1924x1556, fundus photo: 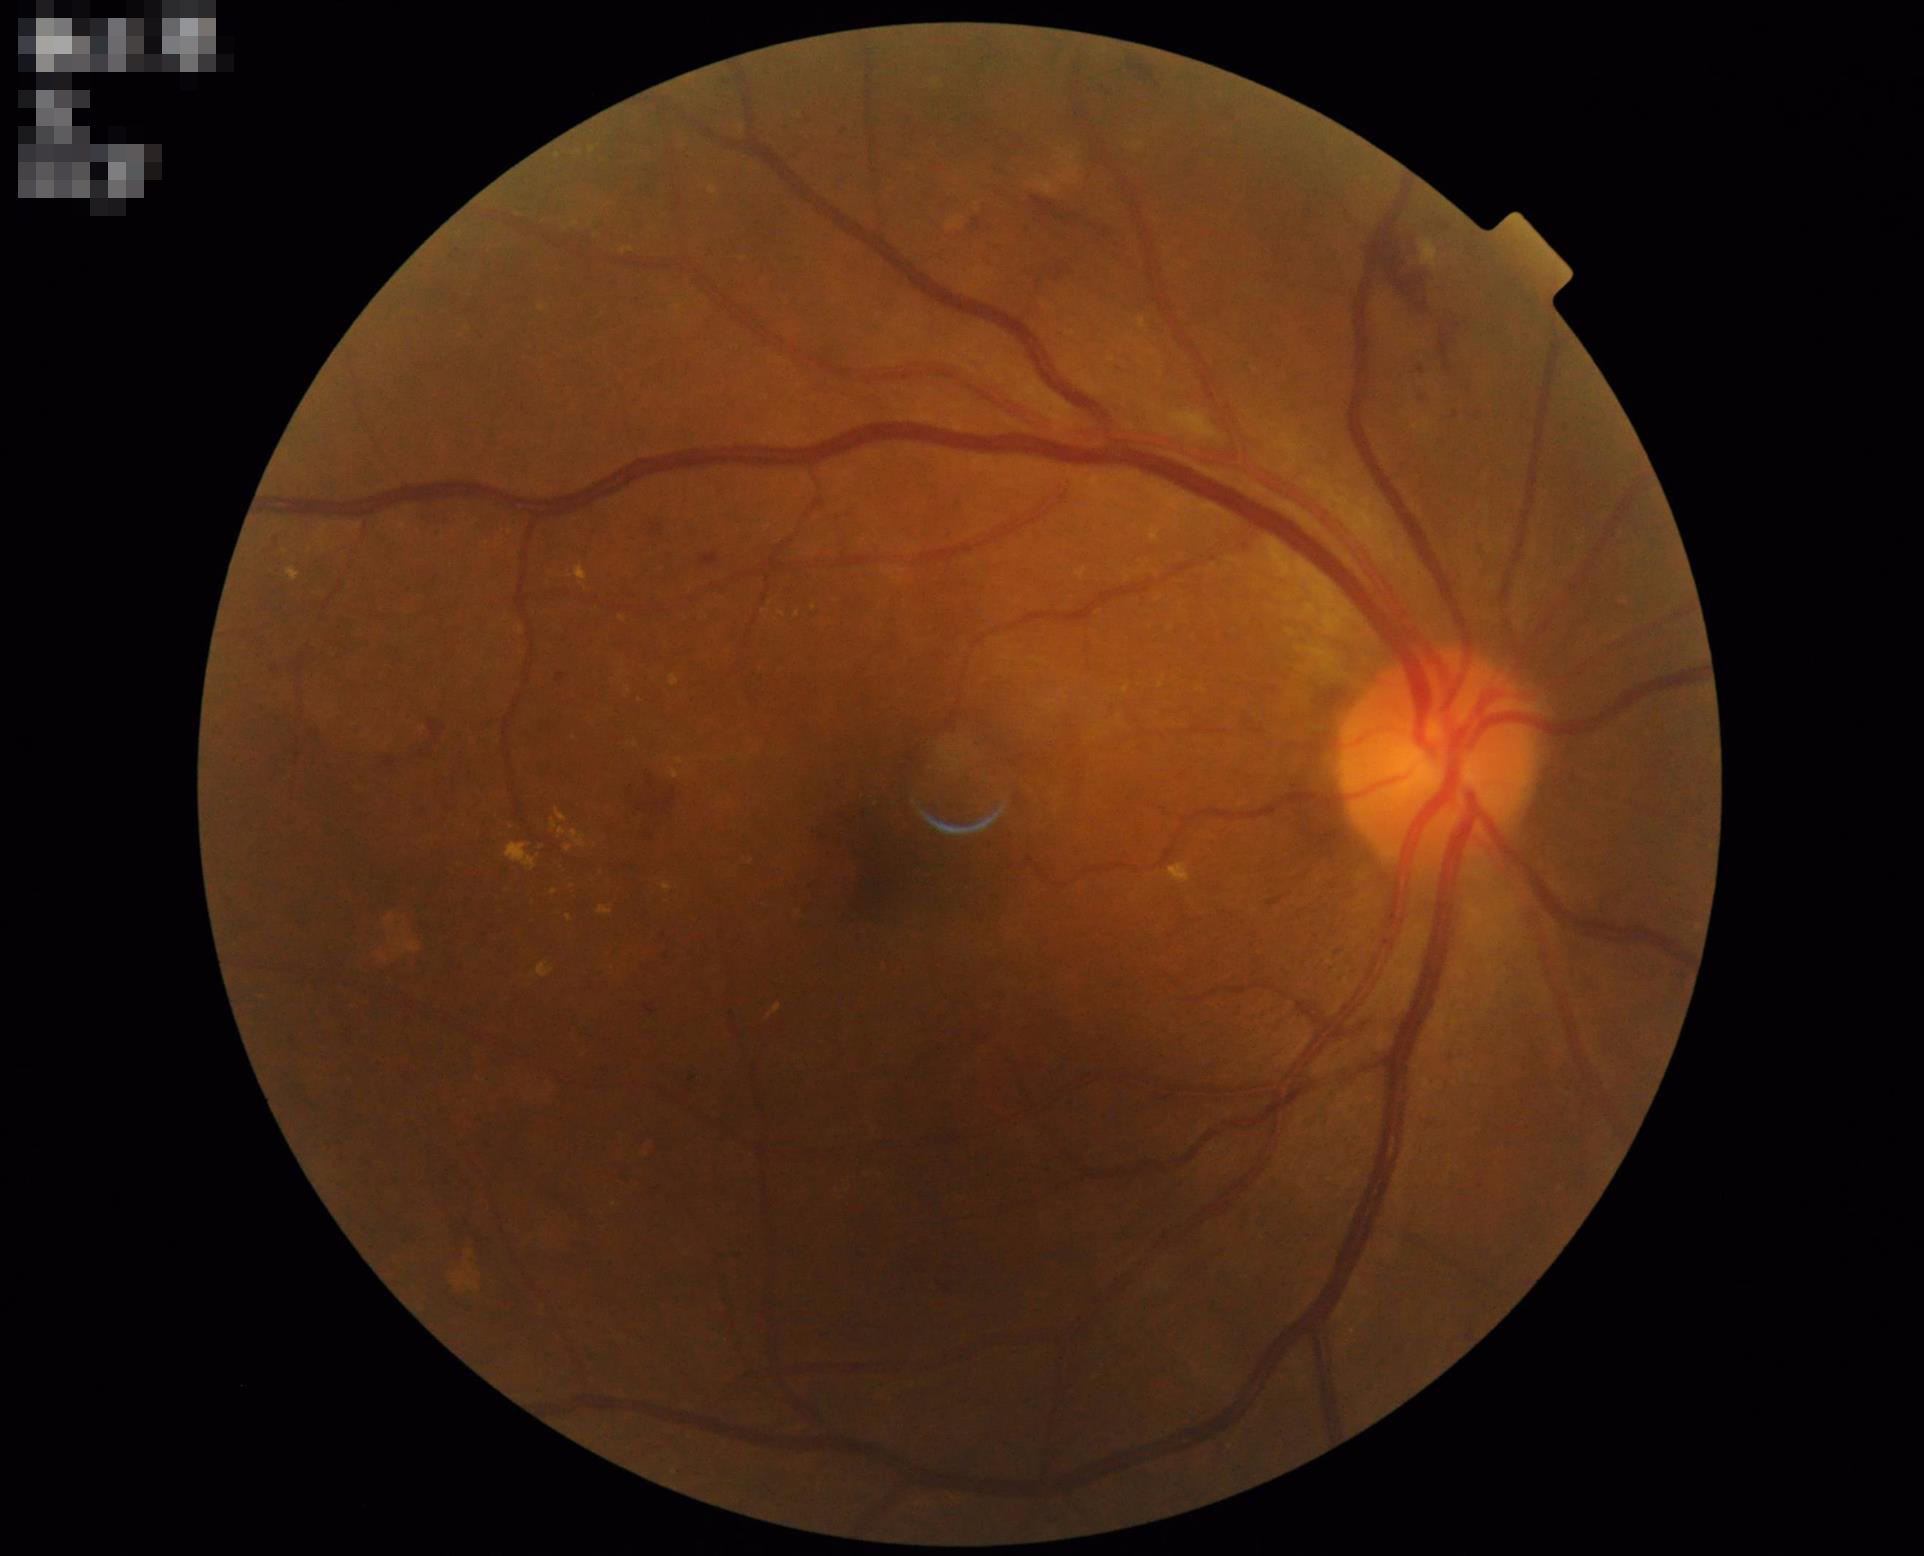
Image quality: focus: clear; contrast: satisfactory; overall: good.